Davis DR grading: 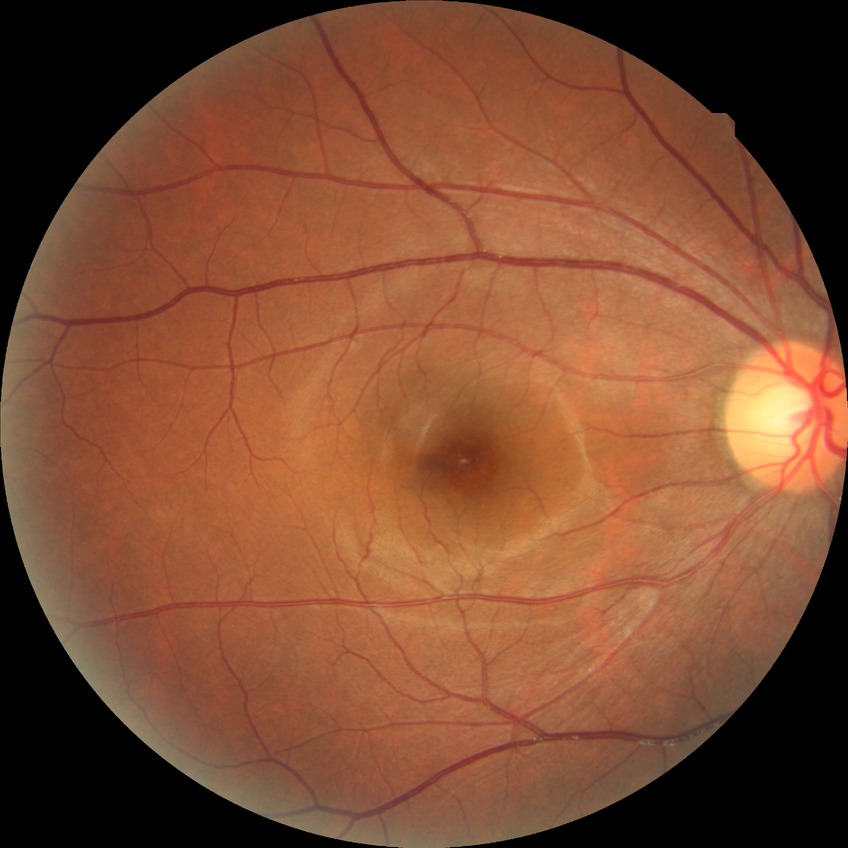 Davis grading is no diabetic retinopathy.